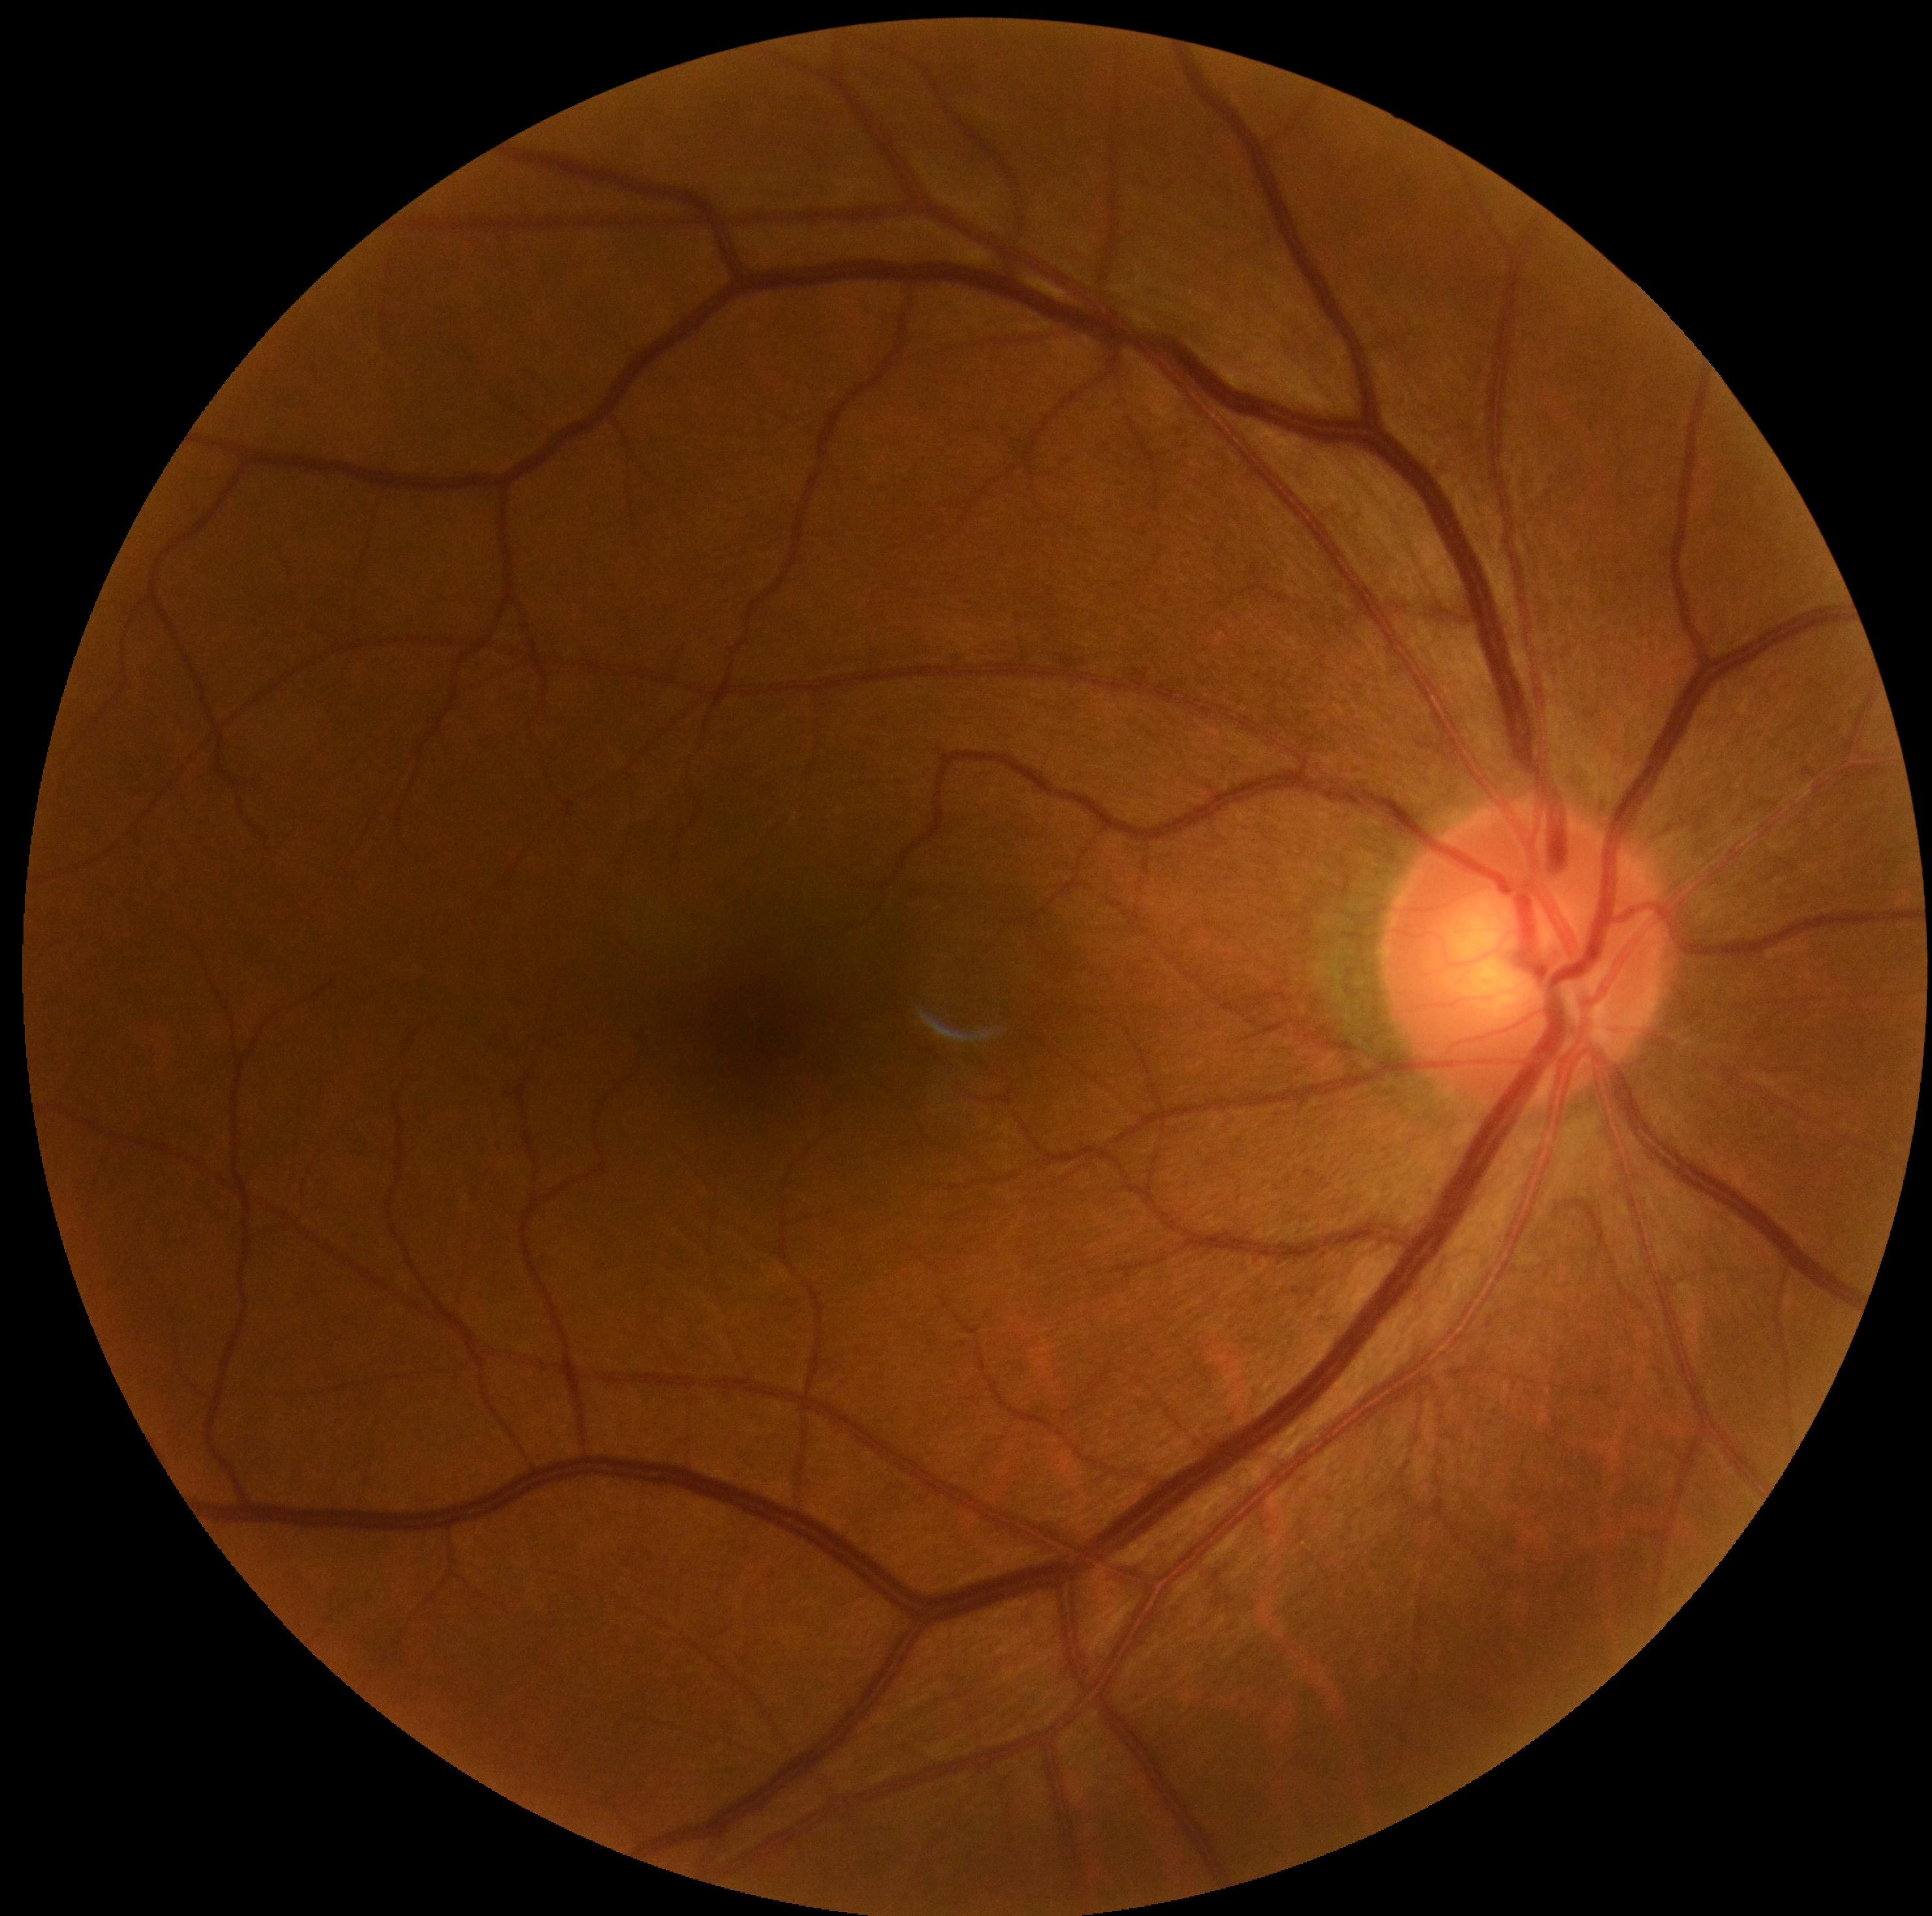
Diabetic retinopathy (DR) is 0.